60° field of view · portable fundus photograph · image size 2212x1659 — 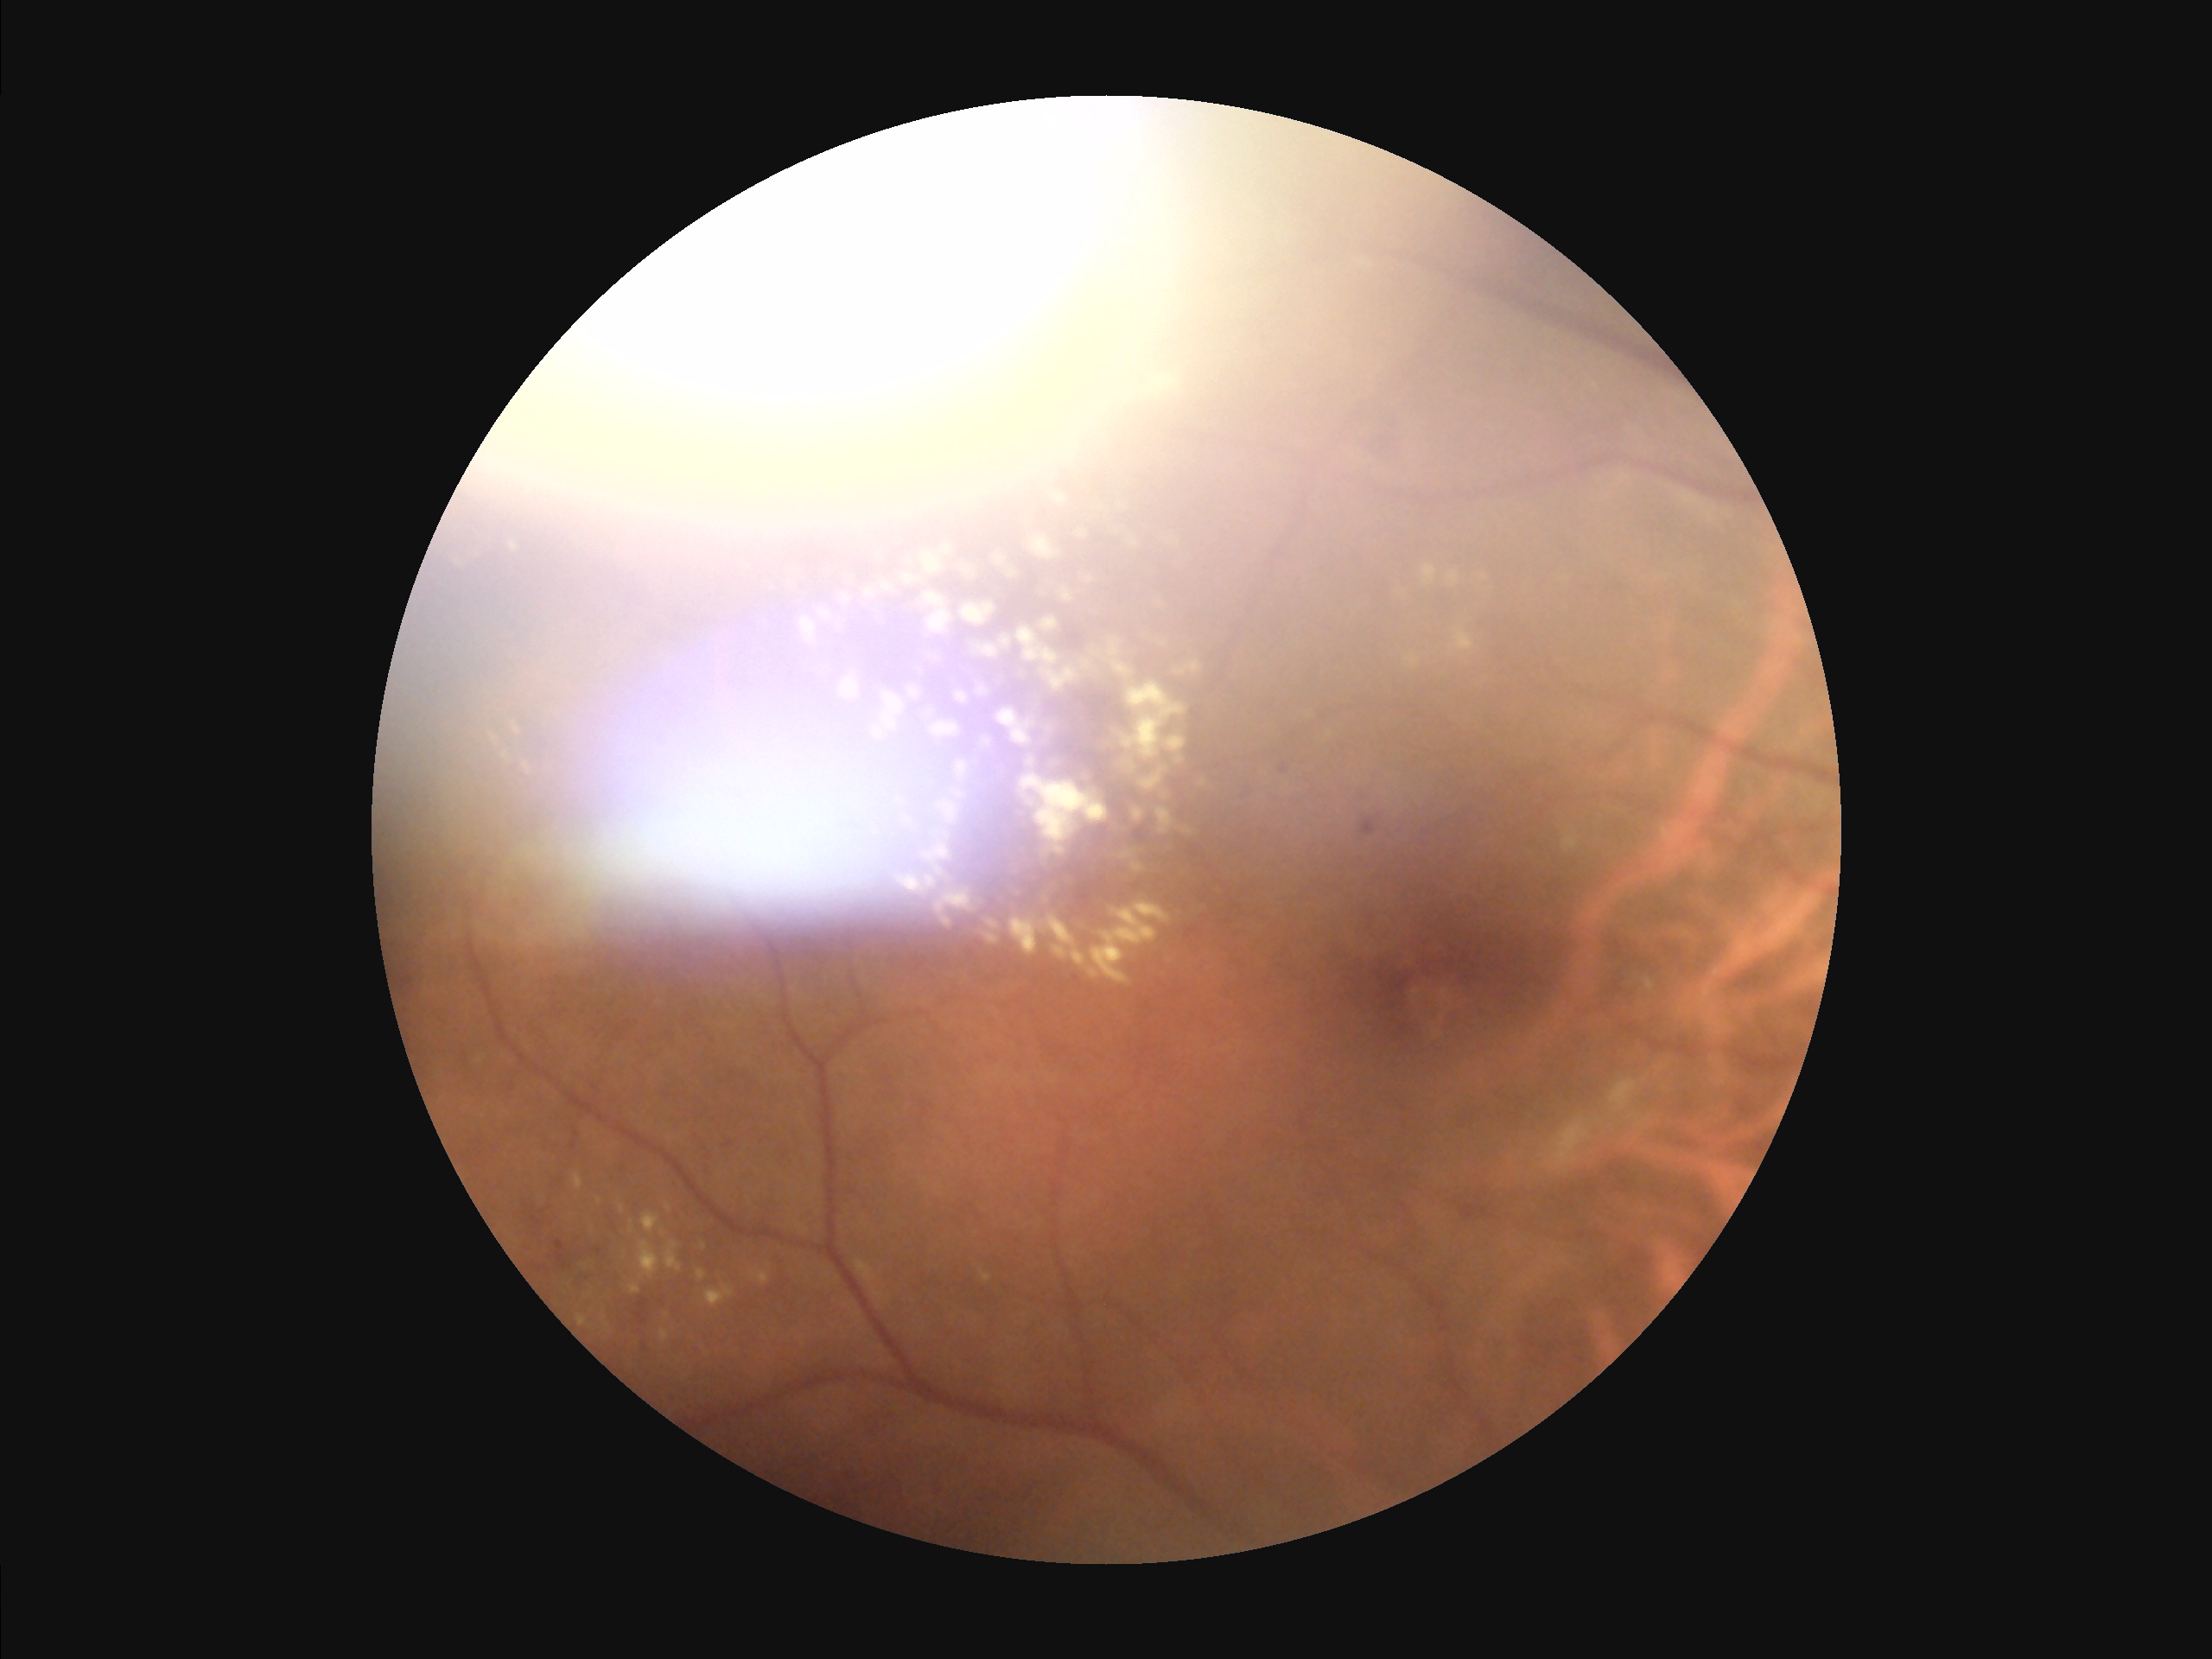
The image is blurry. Poor illumination with uneven exposure. Contrast is low. Image quality is inadequate for diagnostic use.